200-degree field of view. Ultra-widefield fundus photograph. Image size 1924x1556:
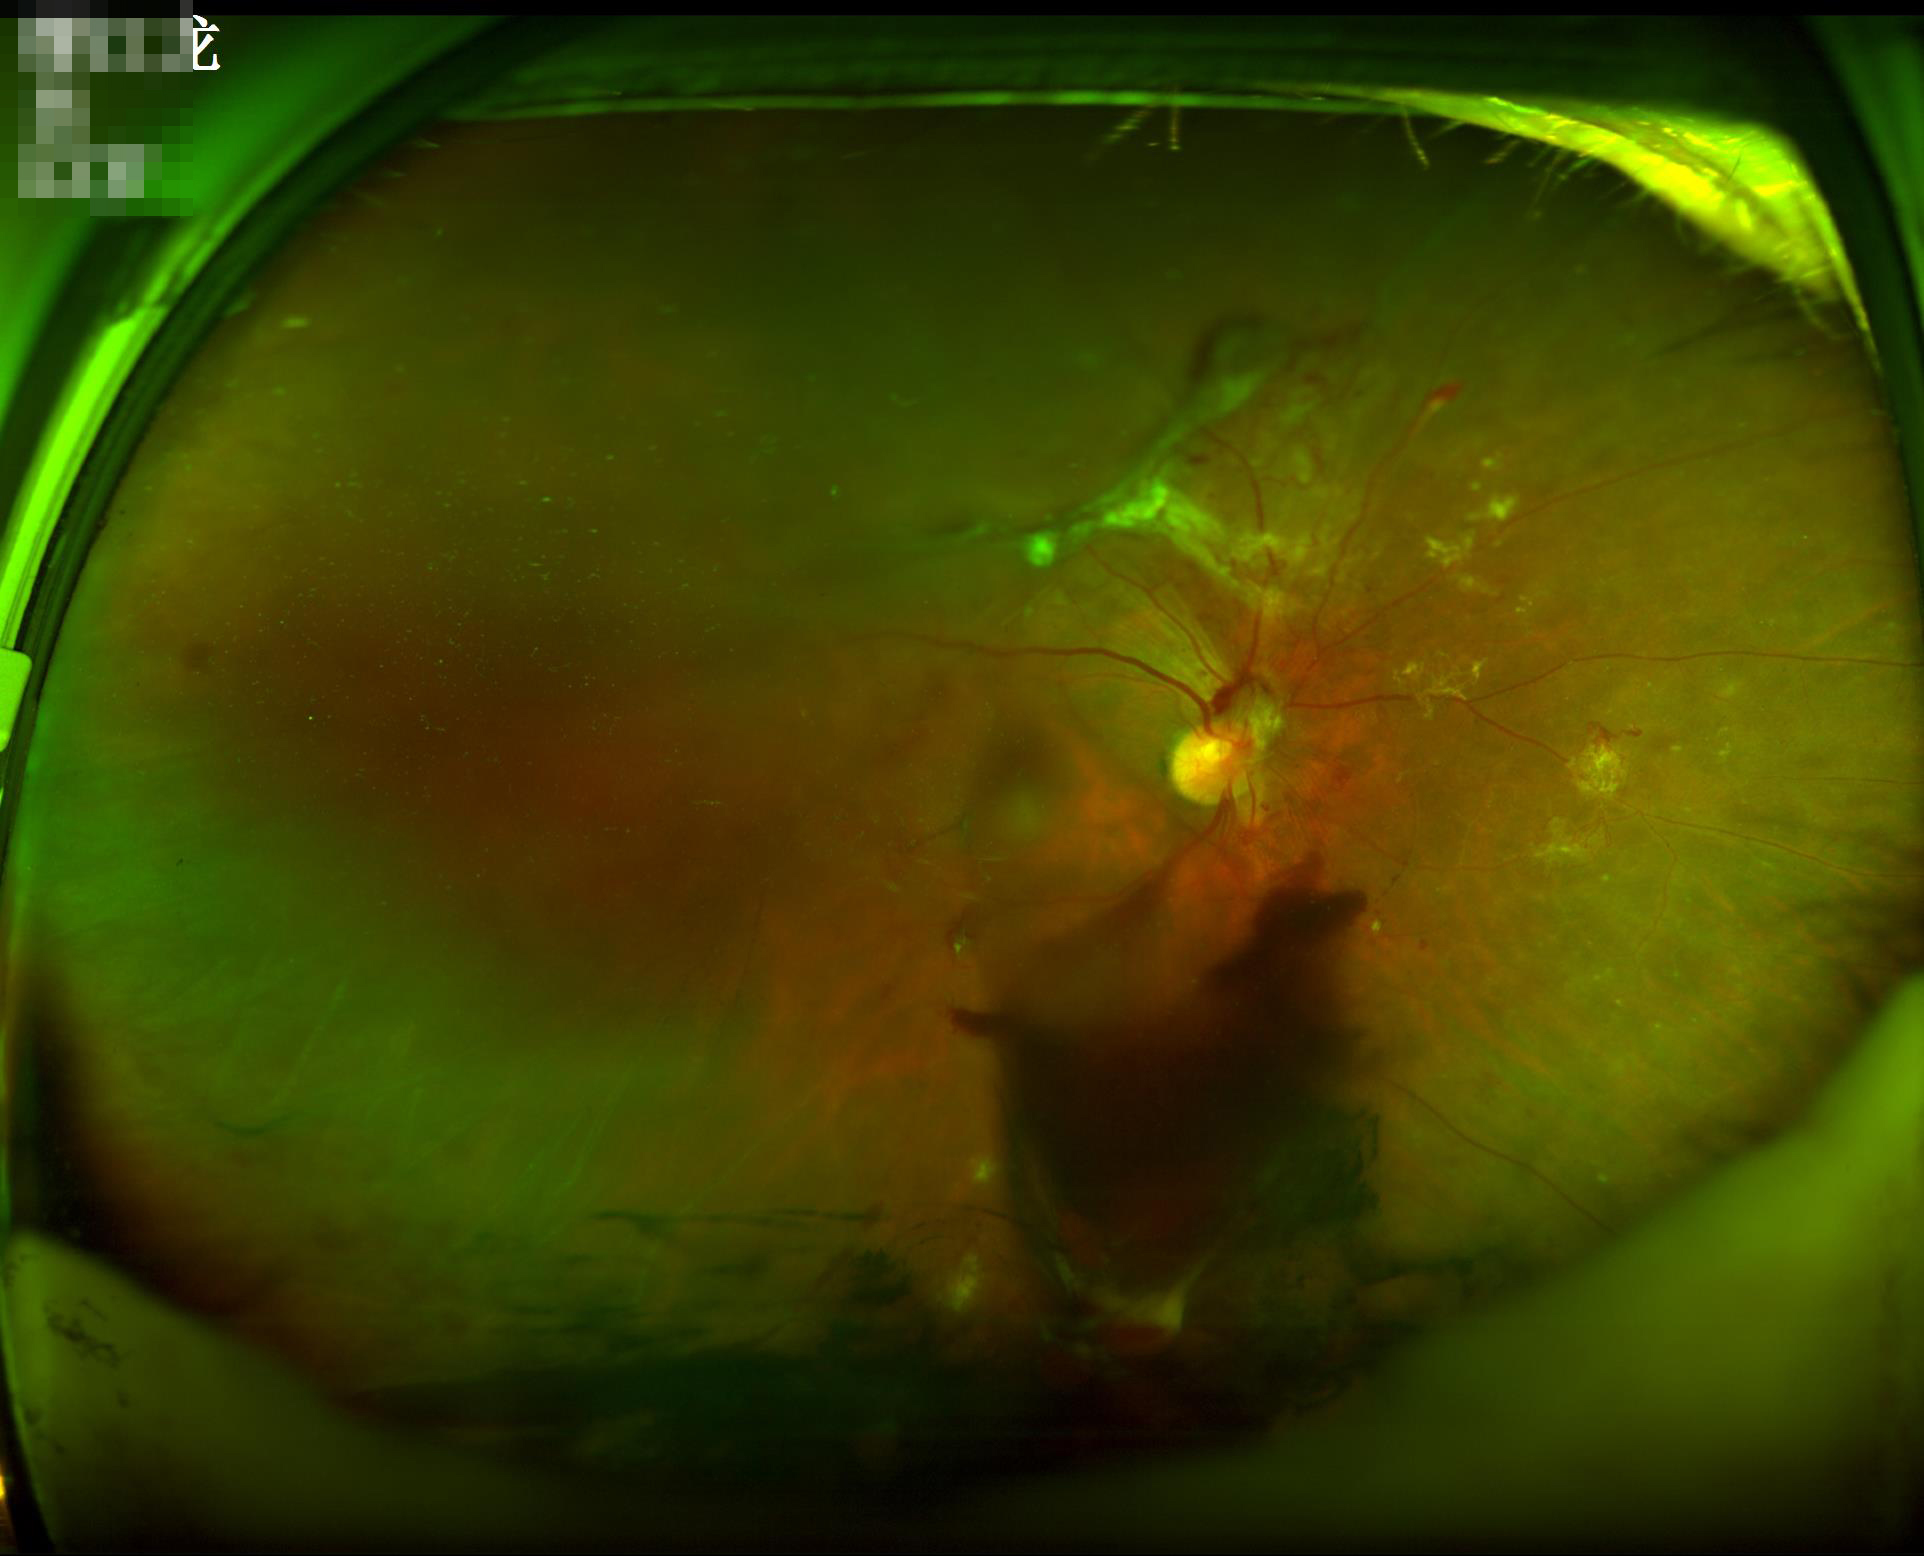
{"clarity": "noticeable blur in the optic disc, vessels, or background", "overall_quality": "inadequate for clinical interpretation", "illumination": "over- or under-exposed", "contrast": "good dynamic range"}